848x848px
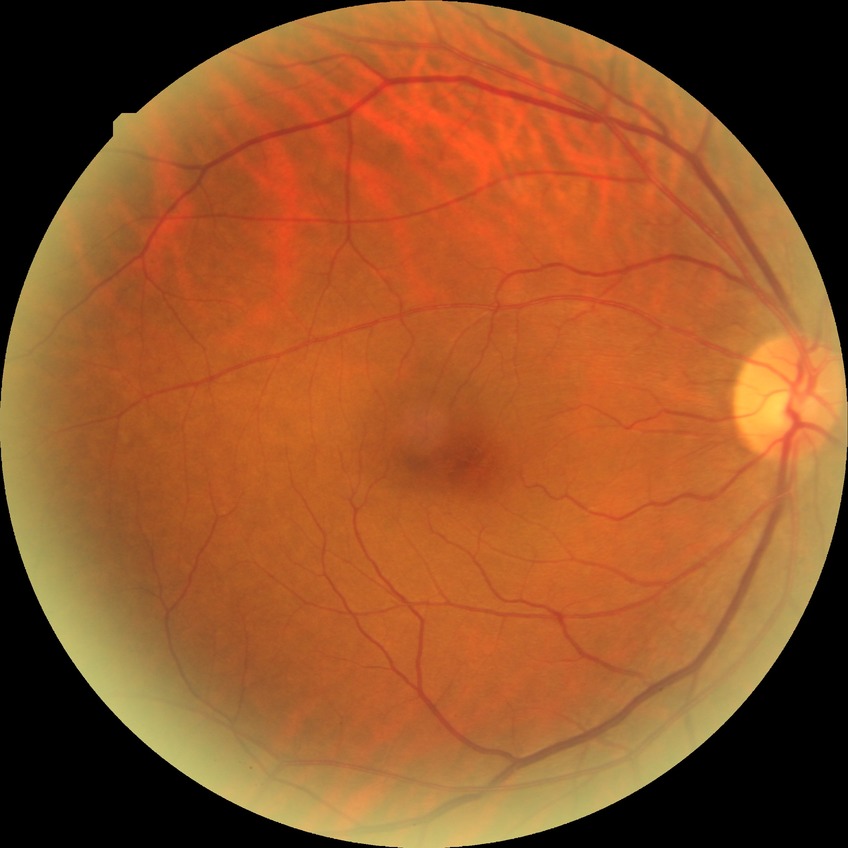 Diabetic retinopathy (DR): no diabetic retinopathy (NDR).